640 by 480 pixels. Wide-field fundus photograph of an infant: 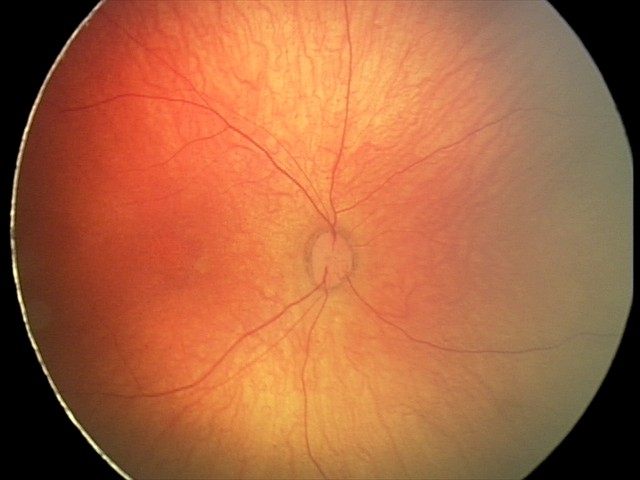 Normal screening examination.